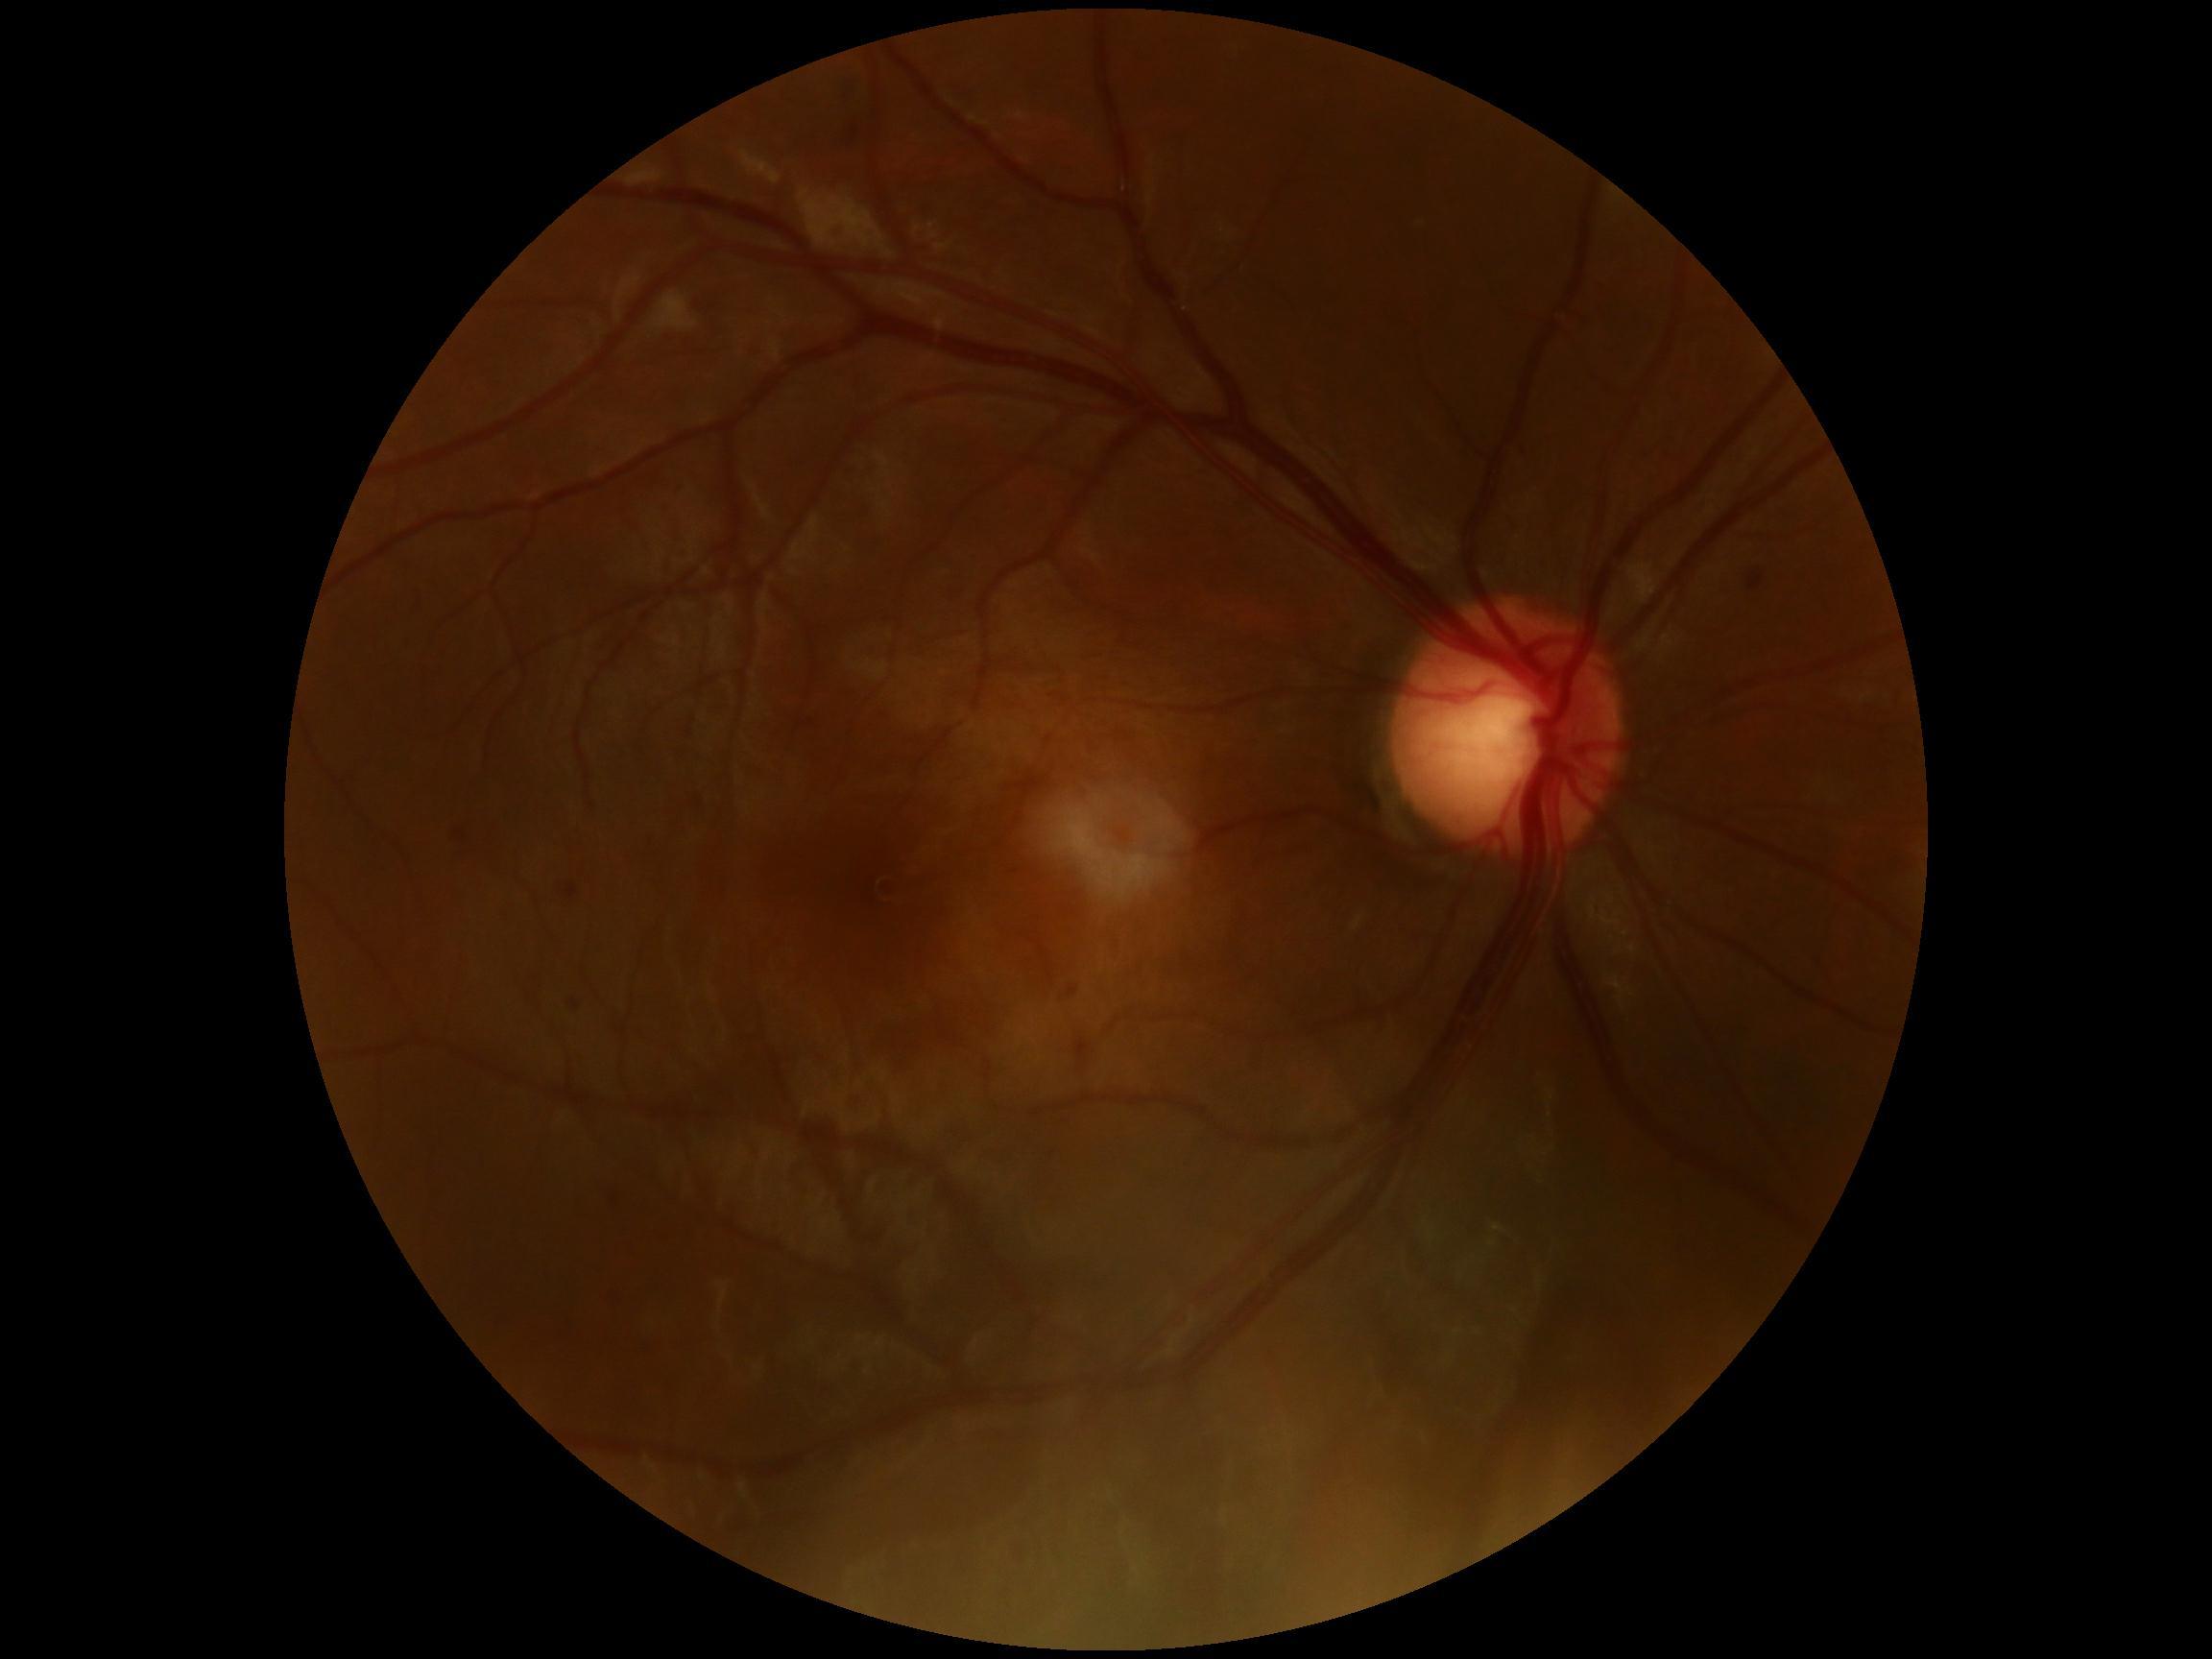

dr_category: non-proliferative diabetic retinopathy
dr_grade: grade 2